2212 x 1659 pixels
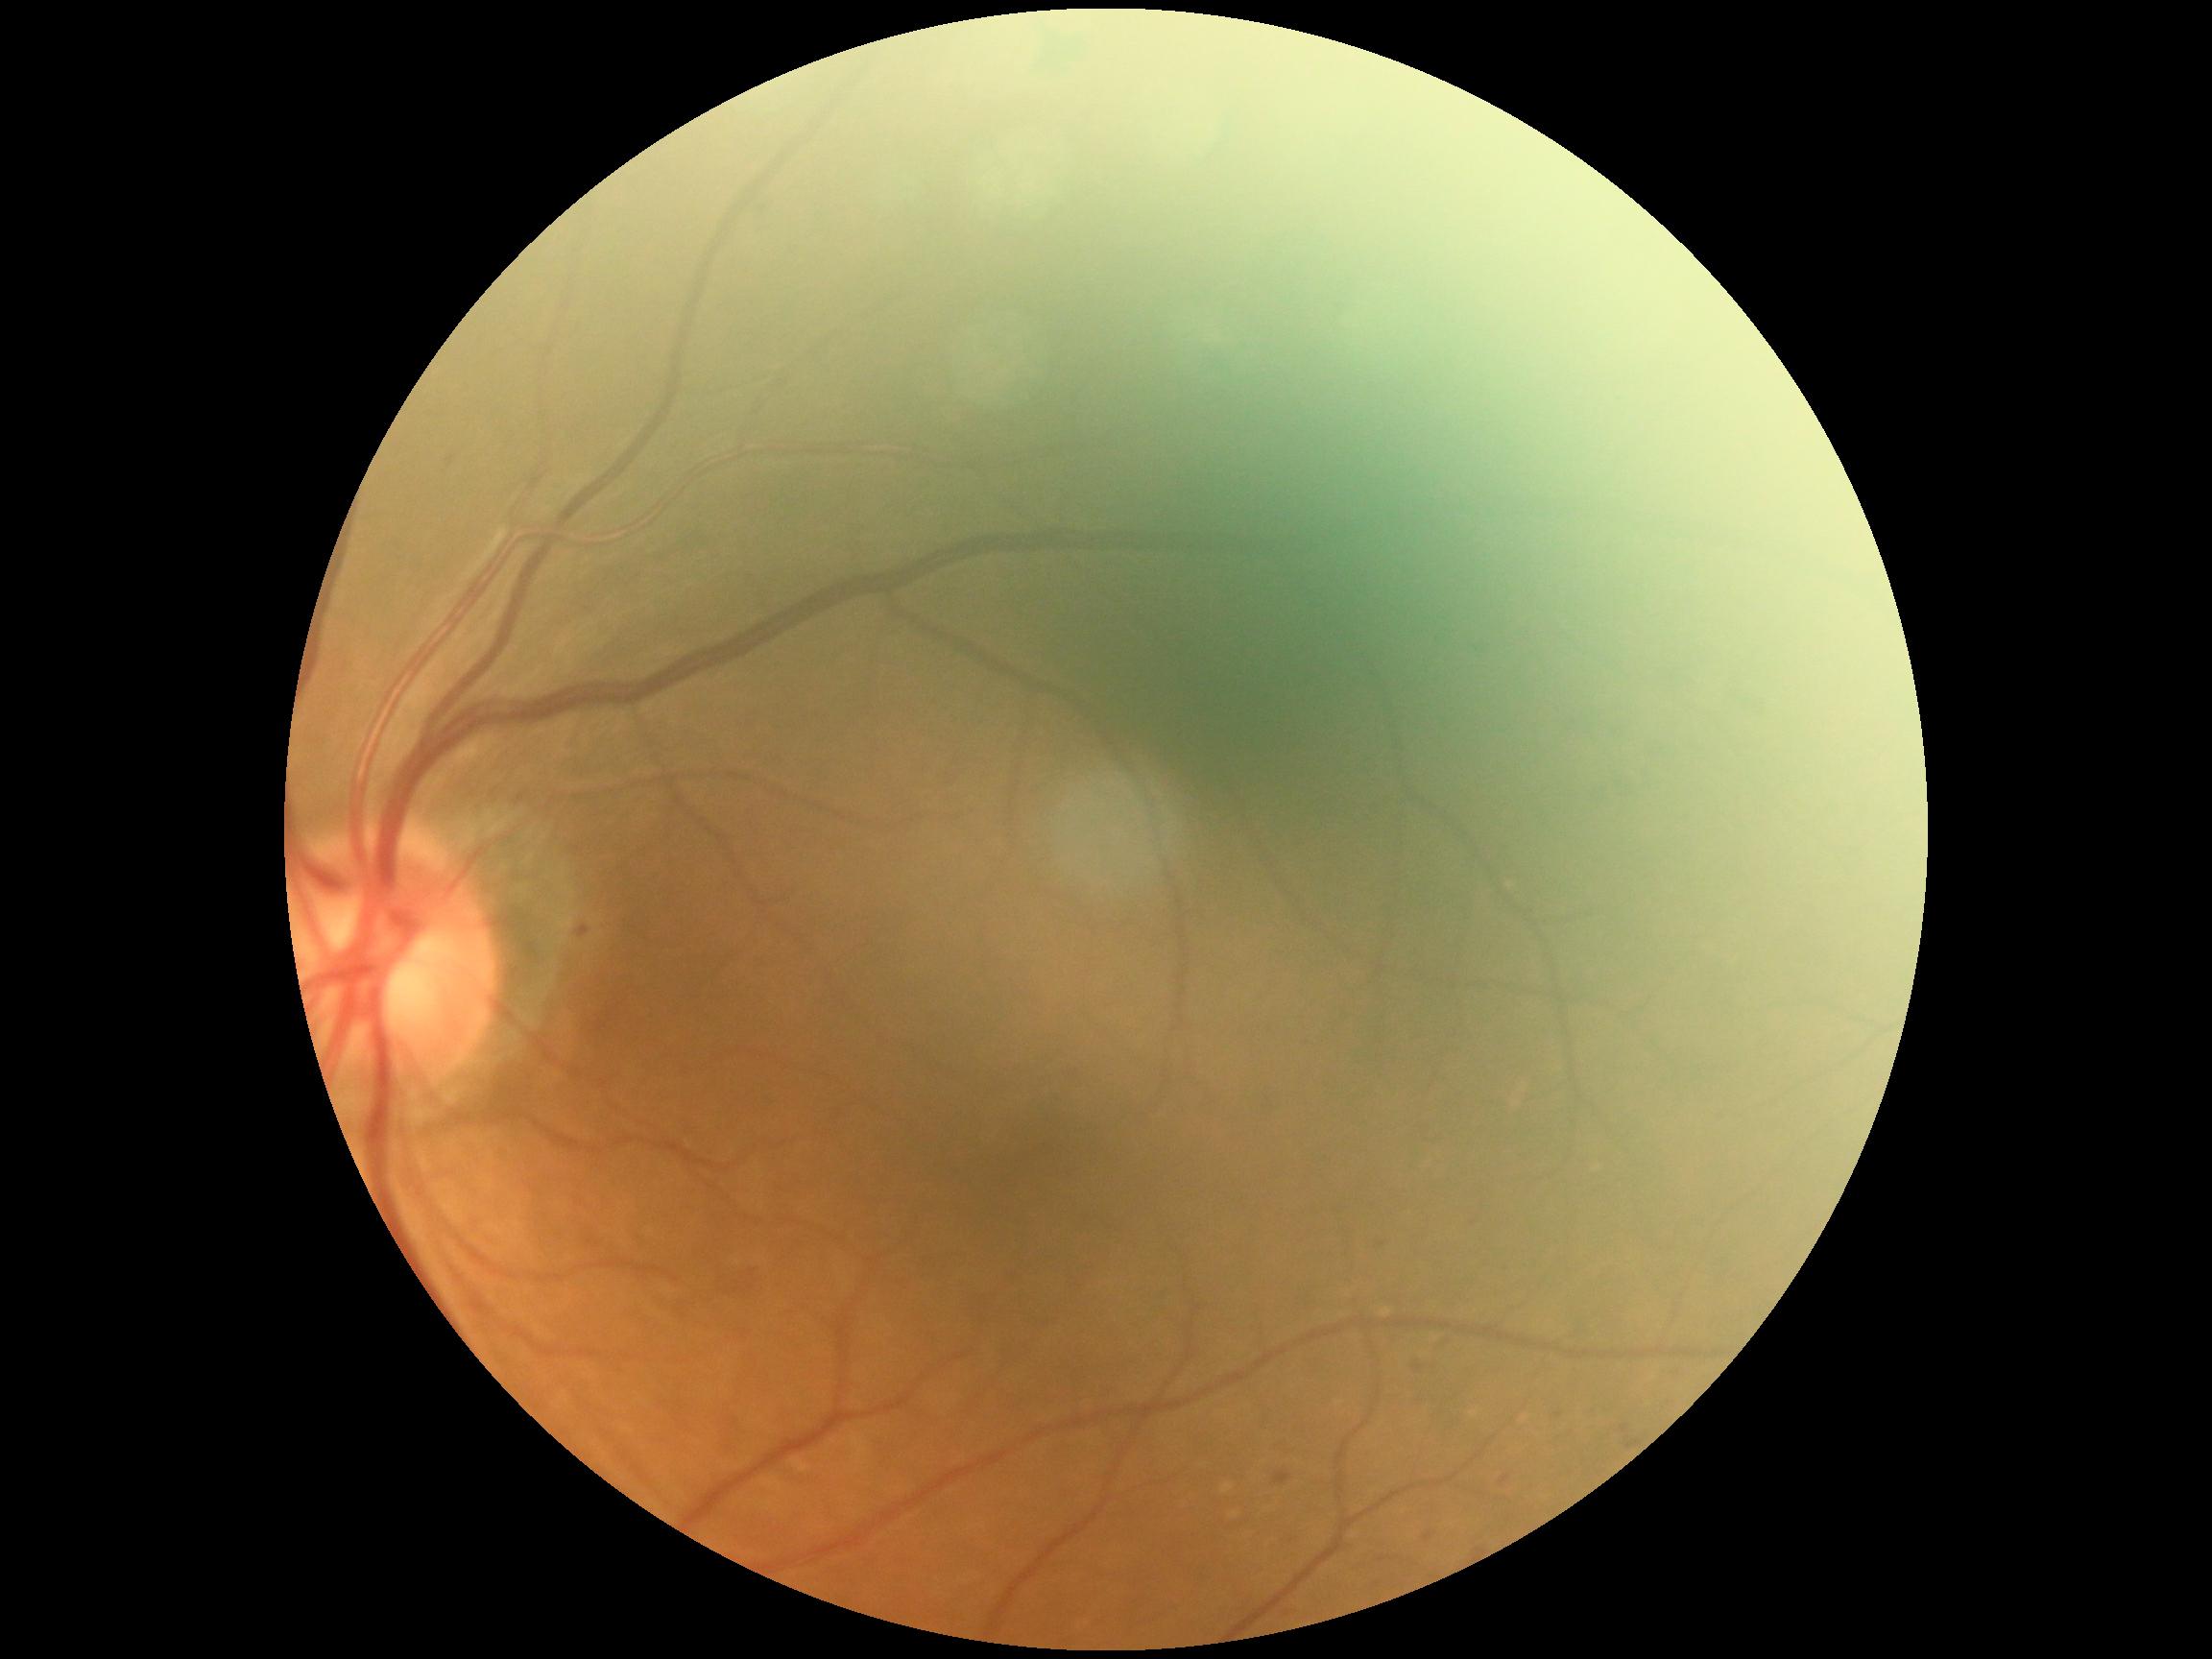 Diabetic retinopathy (DR): 2/4.